Fundus photo, 2212x1659 — 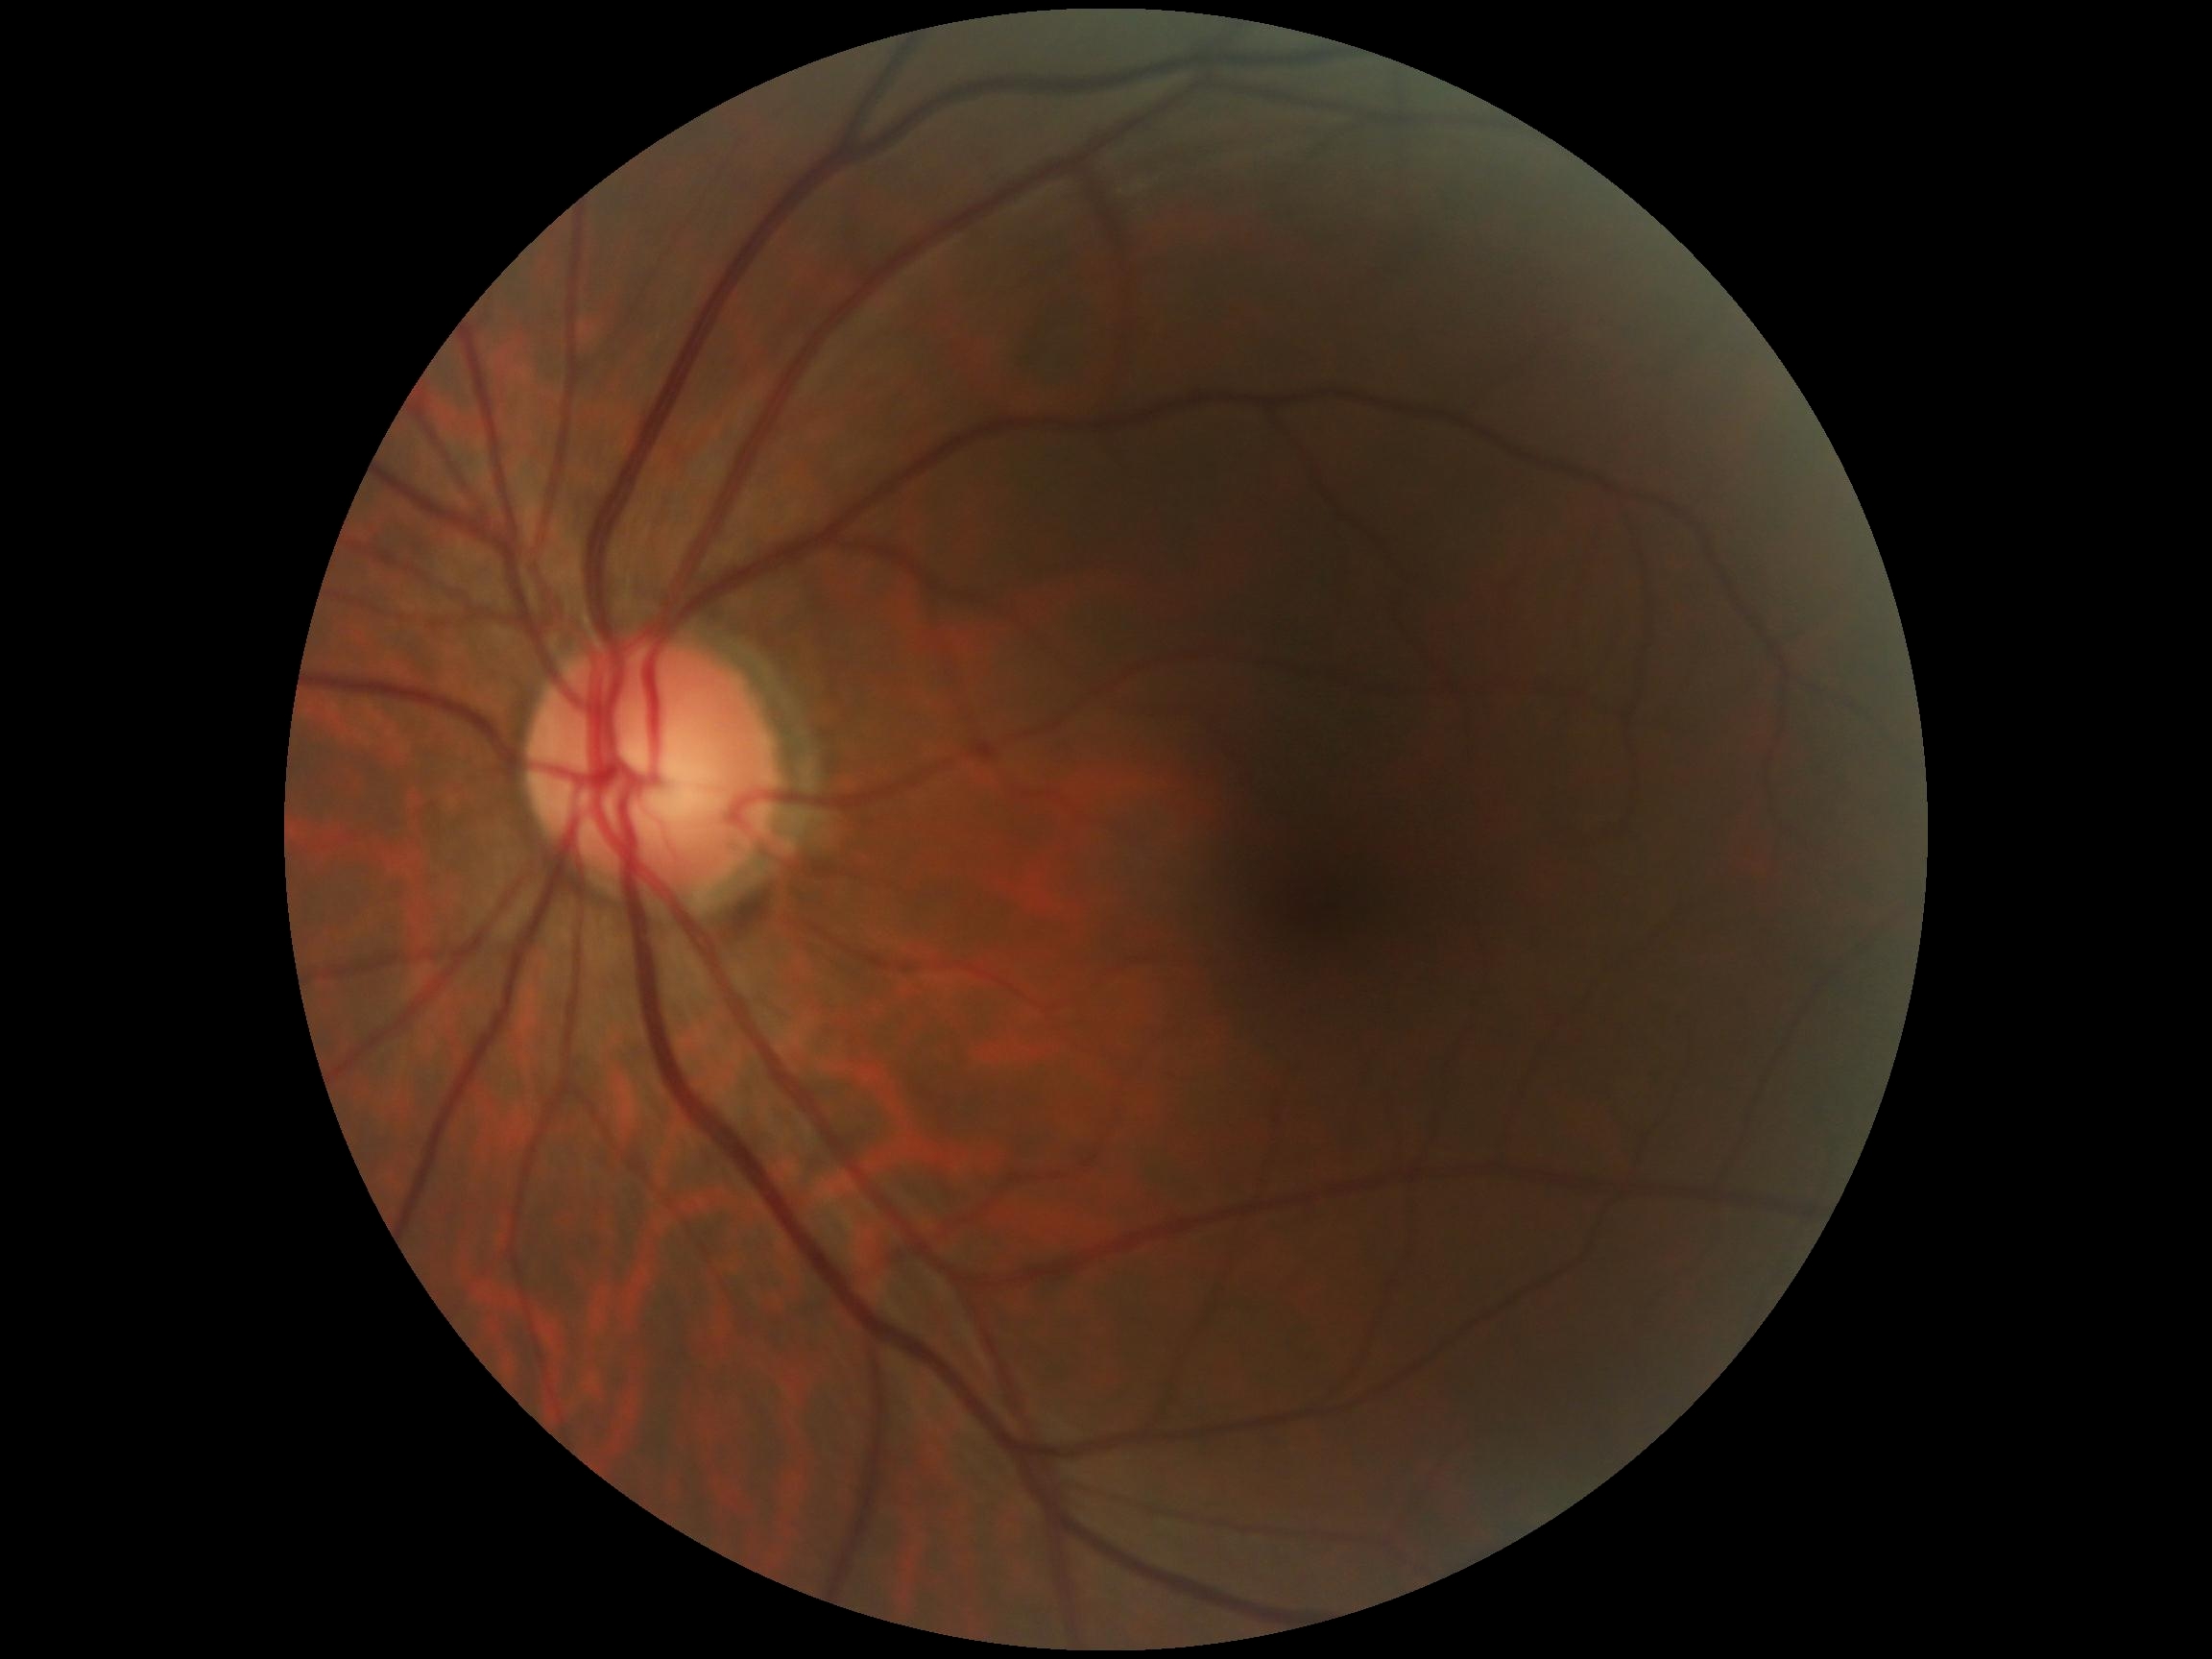
{
  "dr_grade": "no apparent diabetic retinopathy (grade 0)"
}